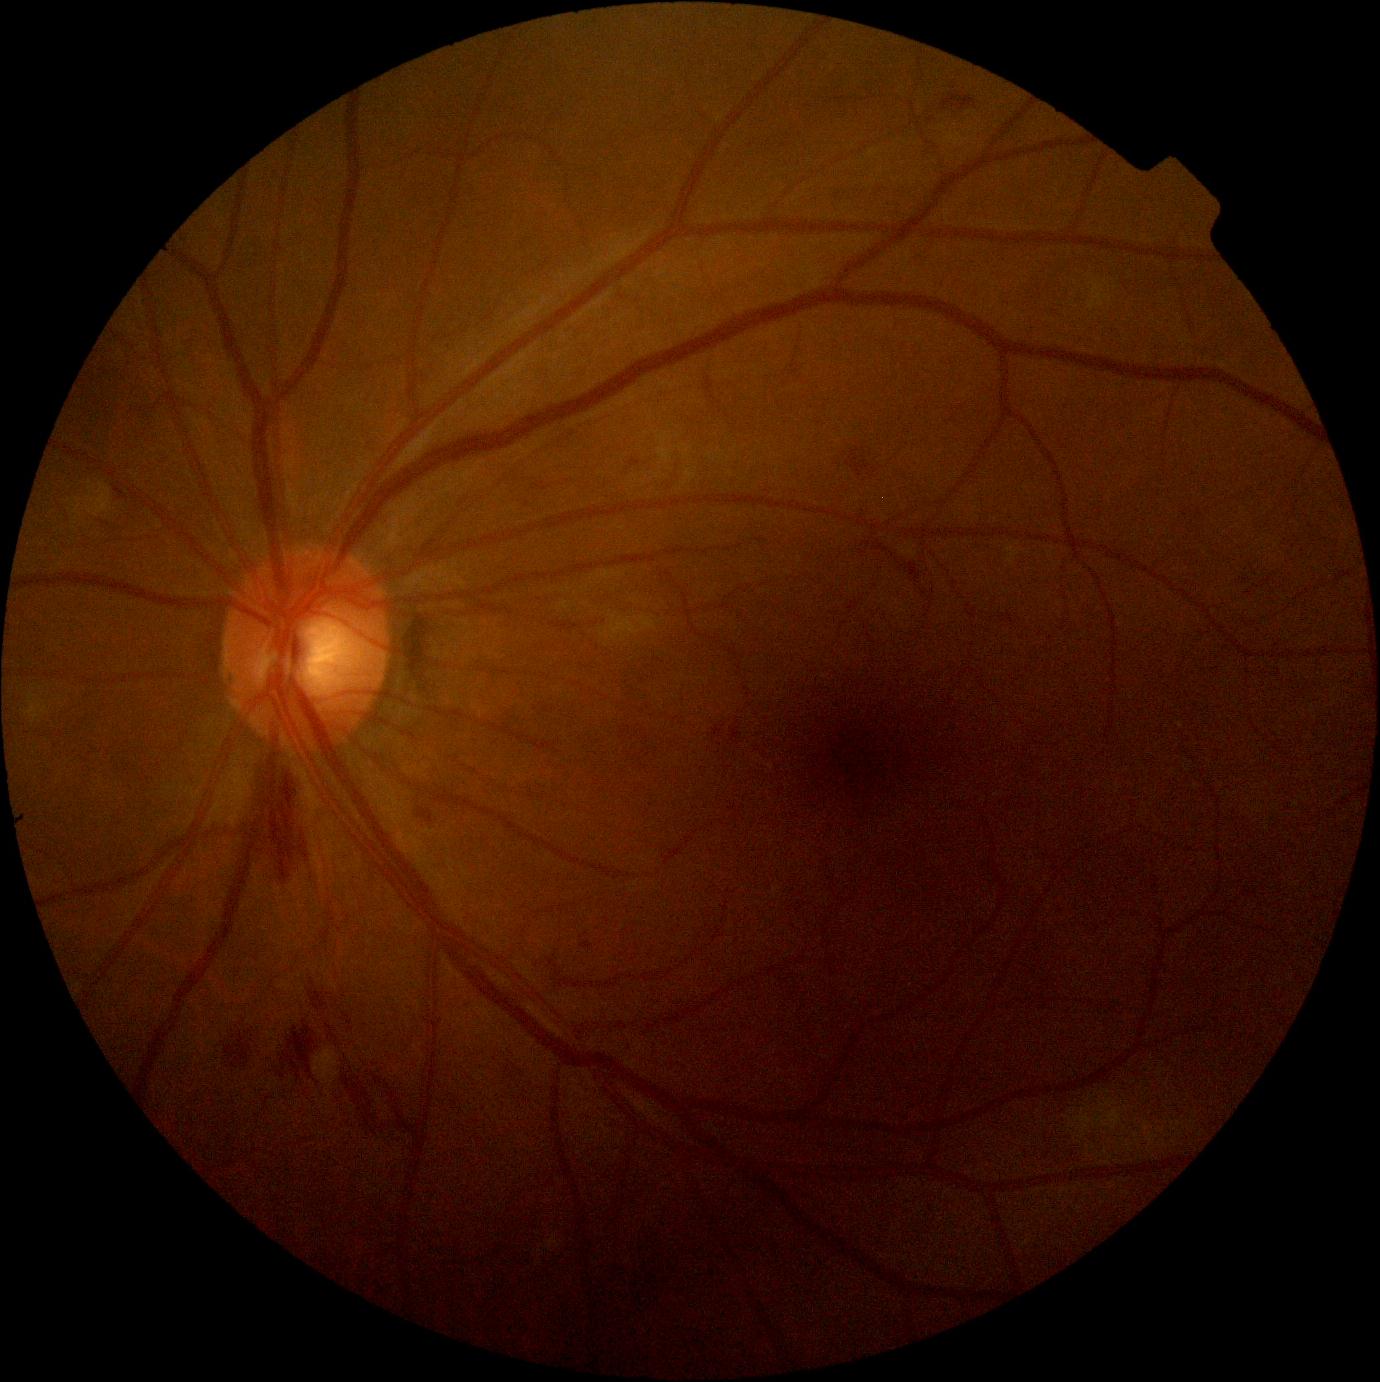
DR stage: 2/4 — more than just microaneurysms but less than severe NPDR.